Image size 1932x1910: 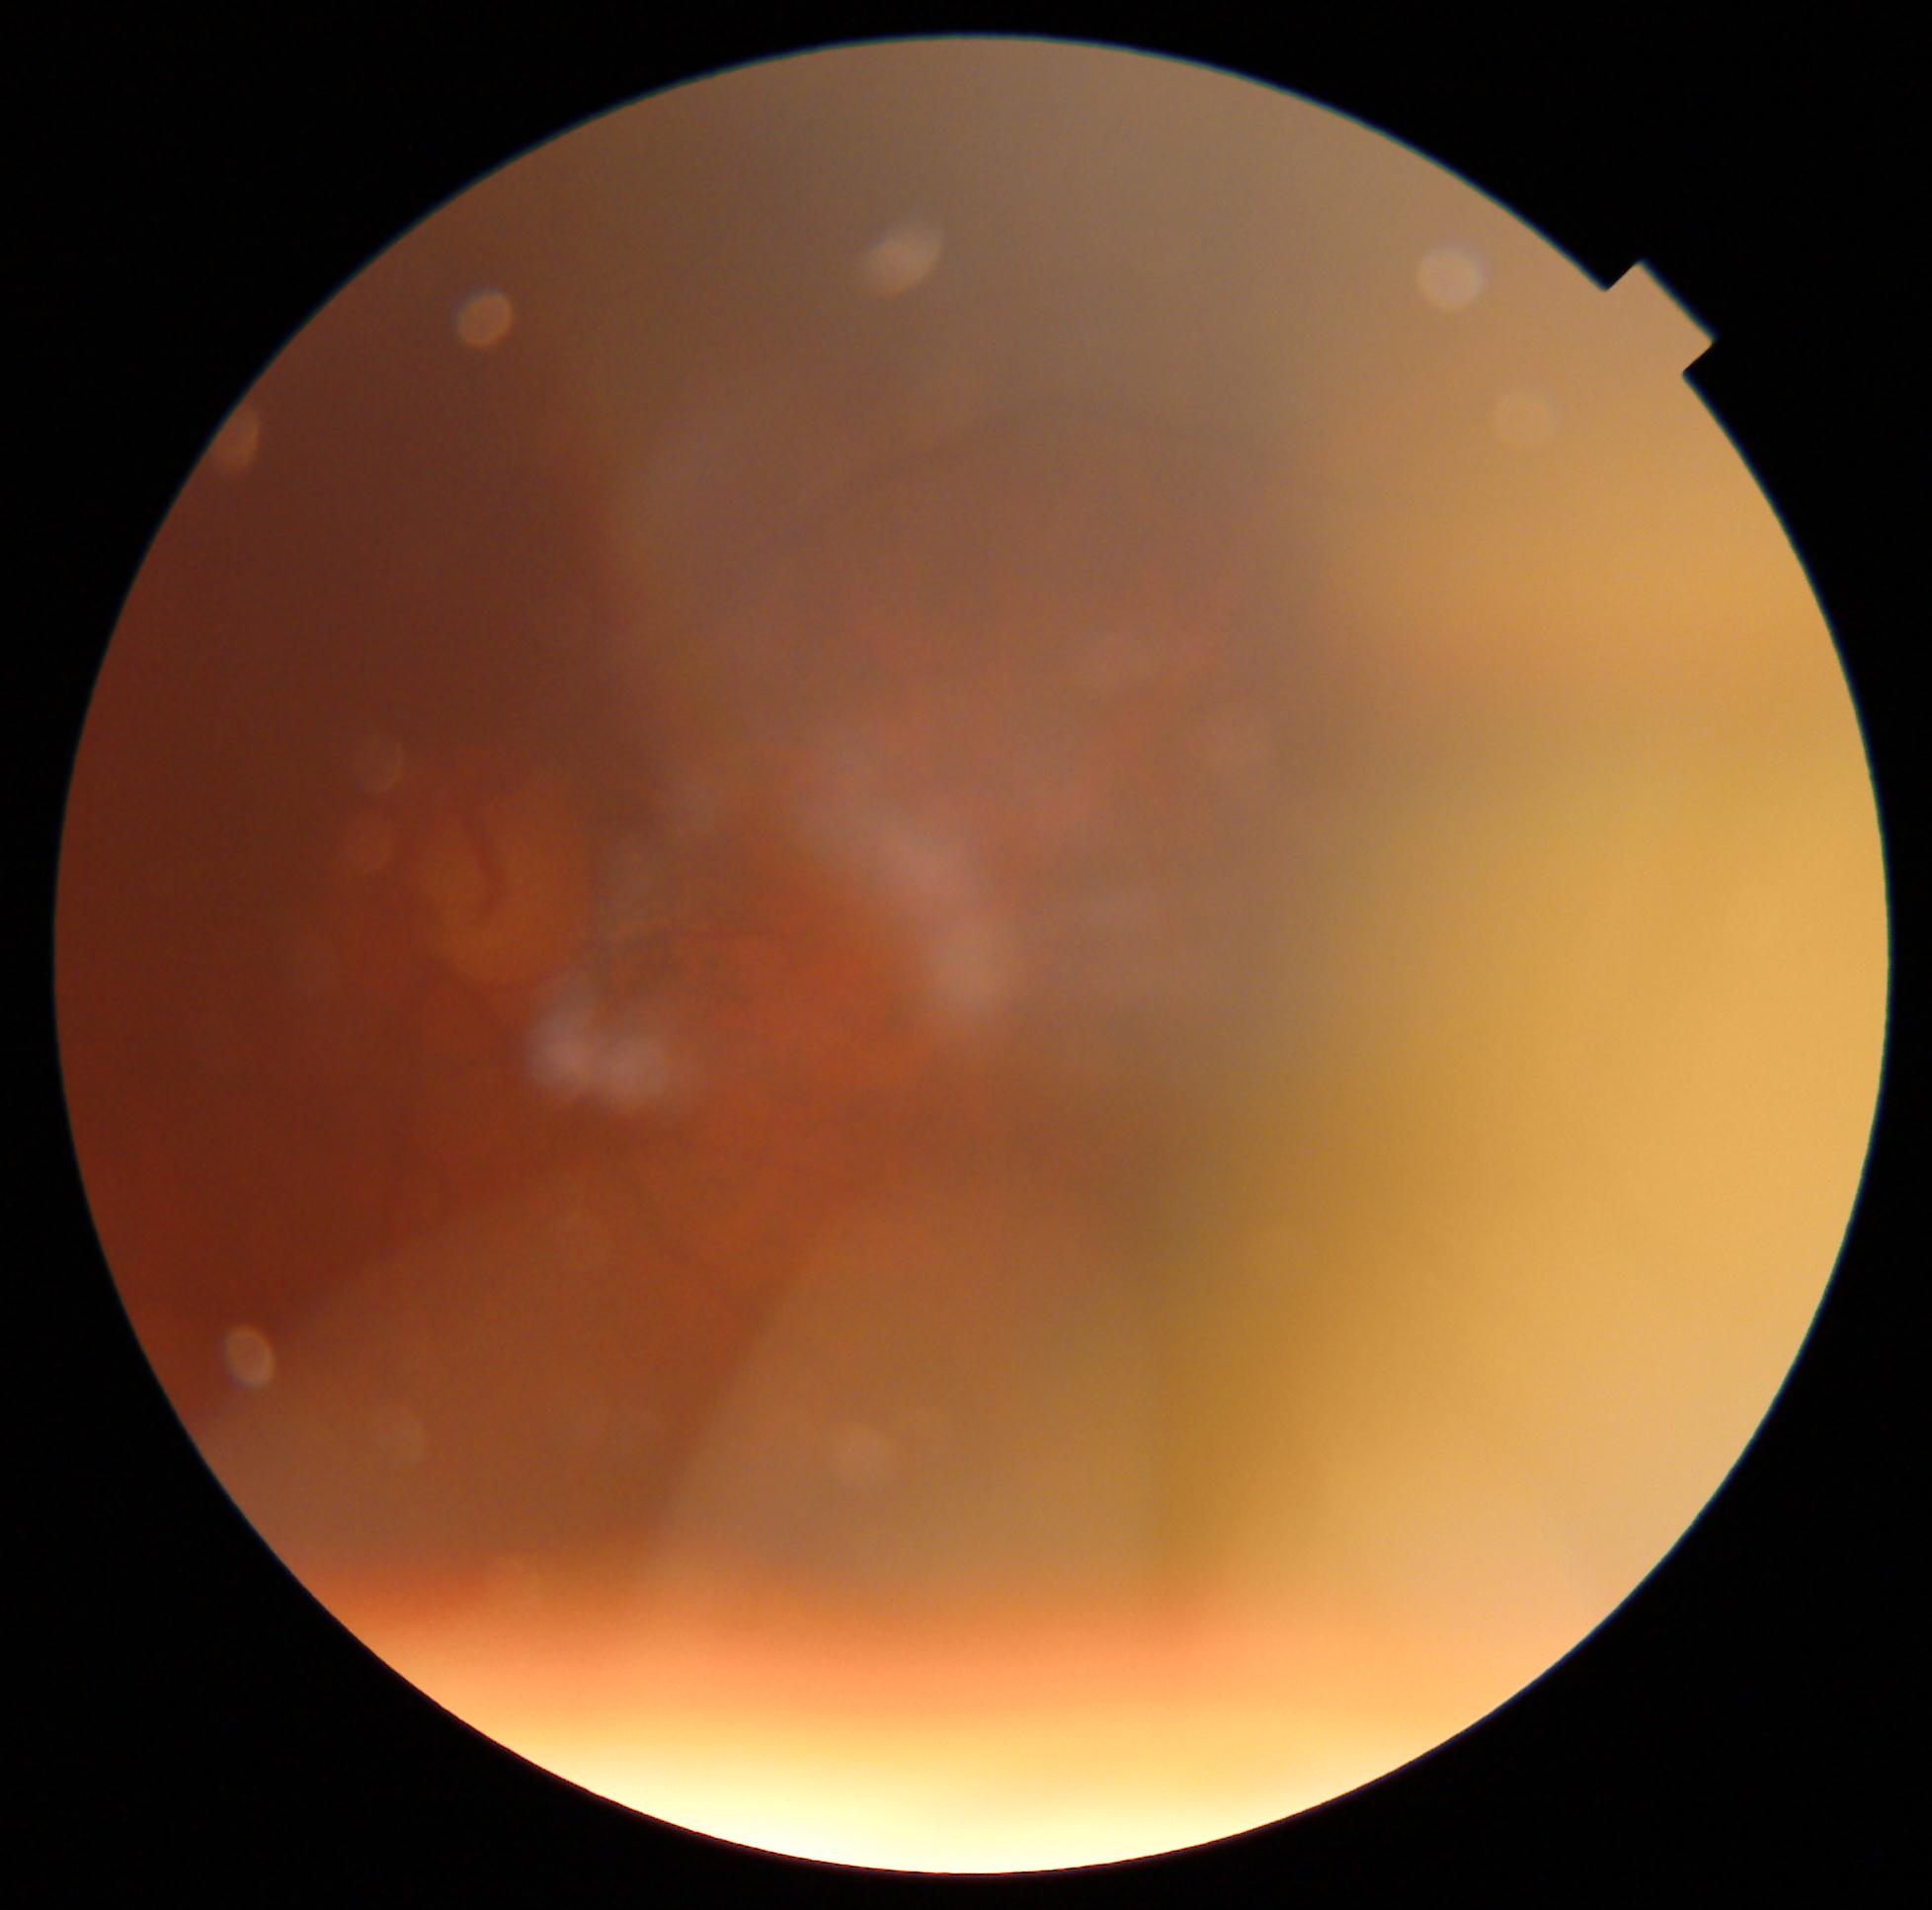
Ungradable image — DR severity cannot be determined. Retinopathy grade is ungradable due to poor image quality.